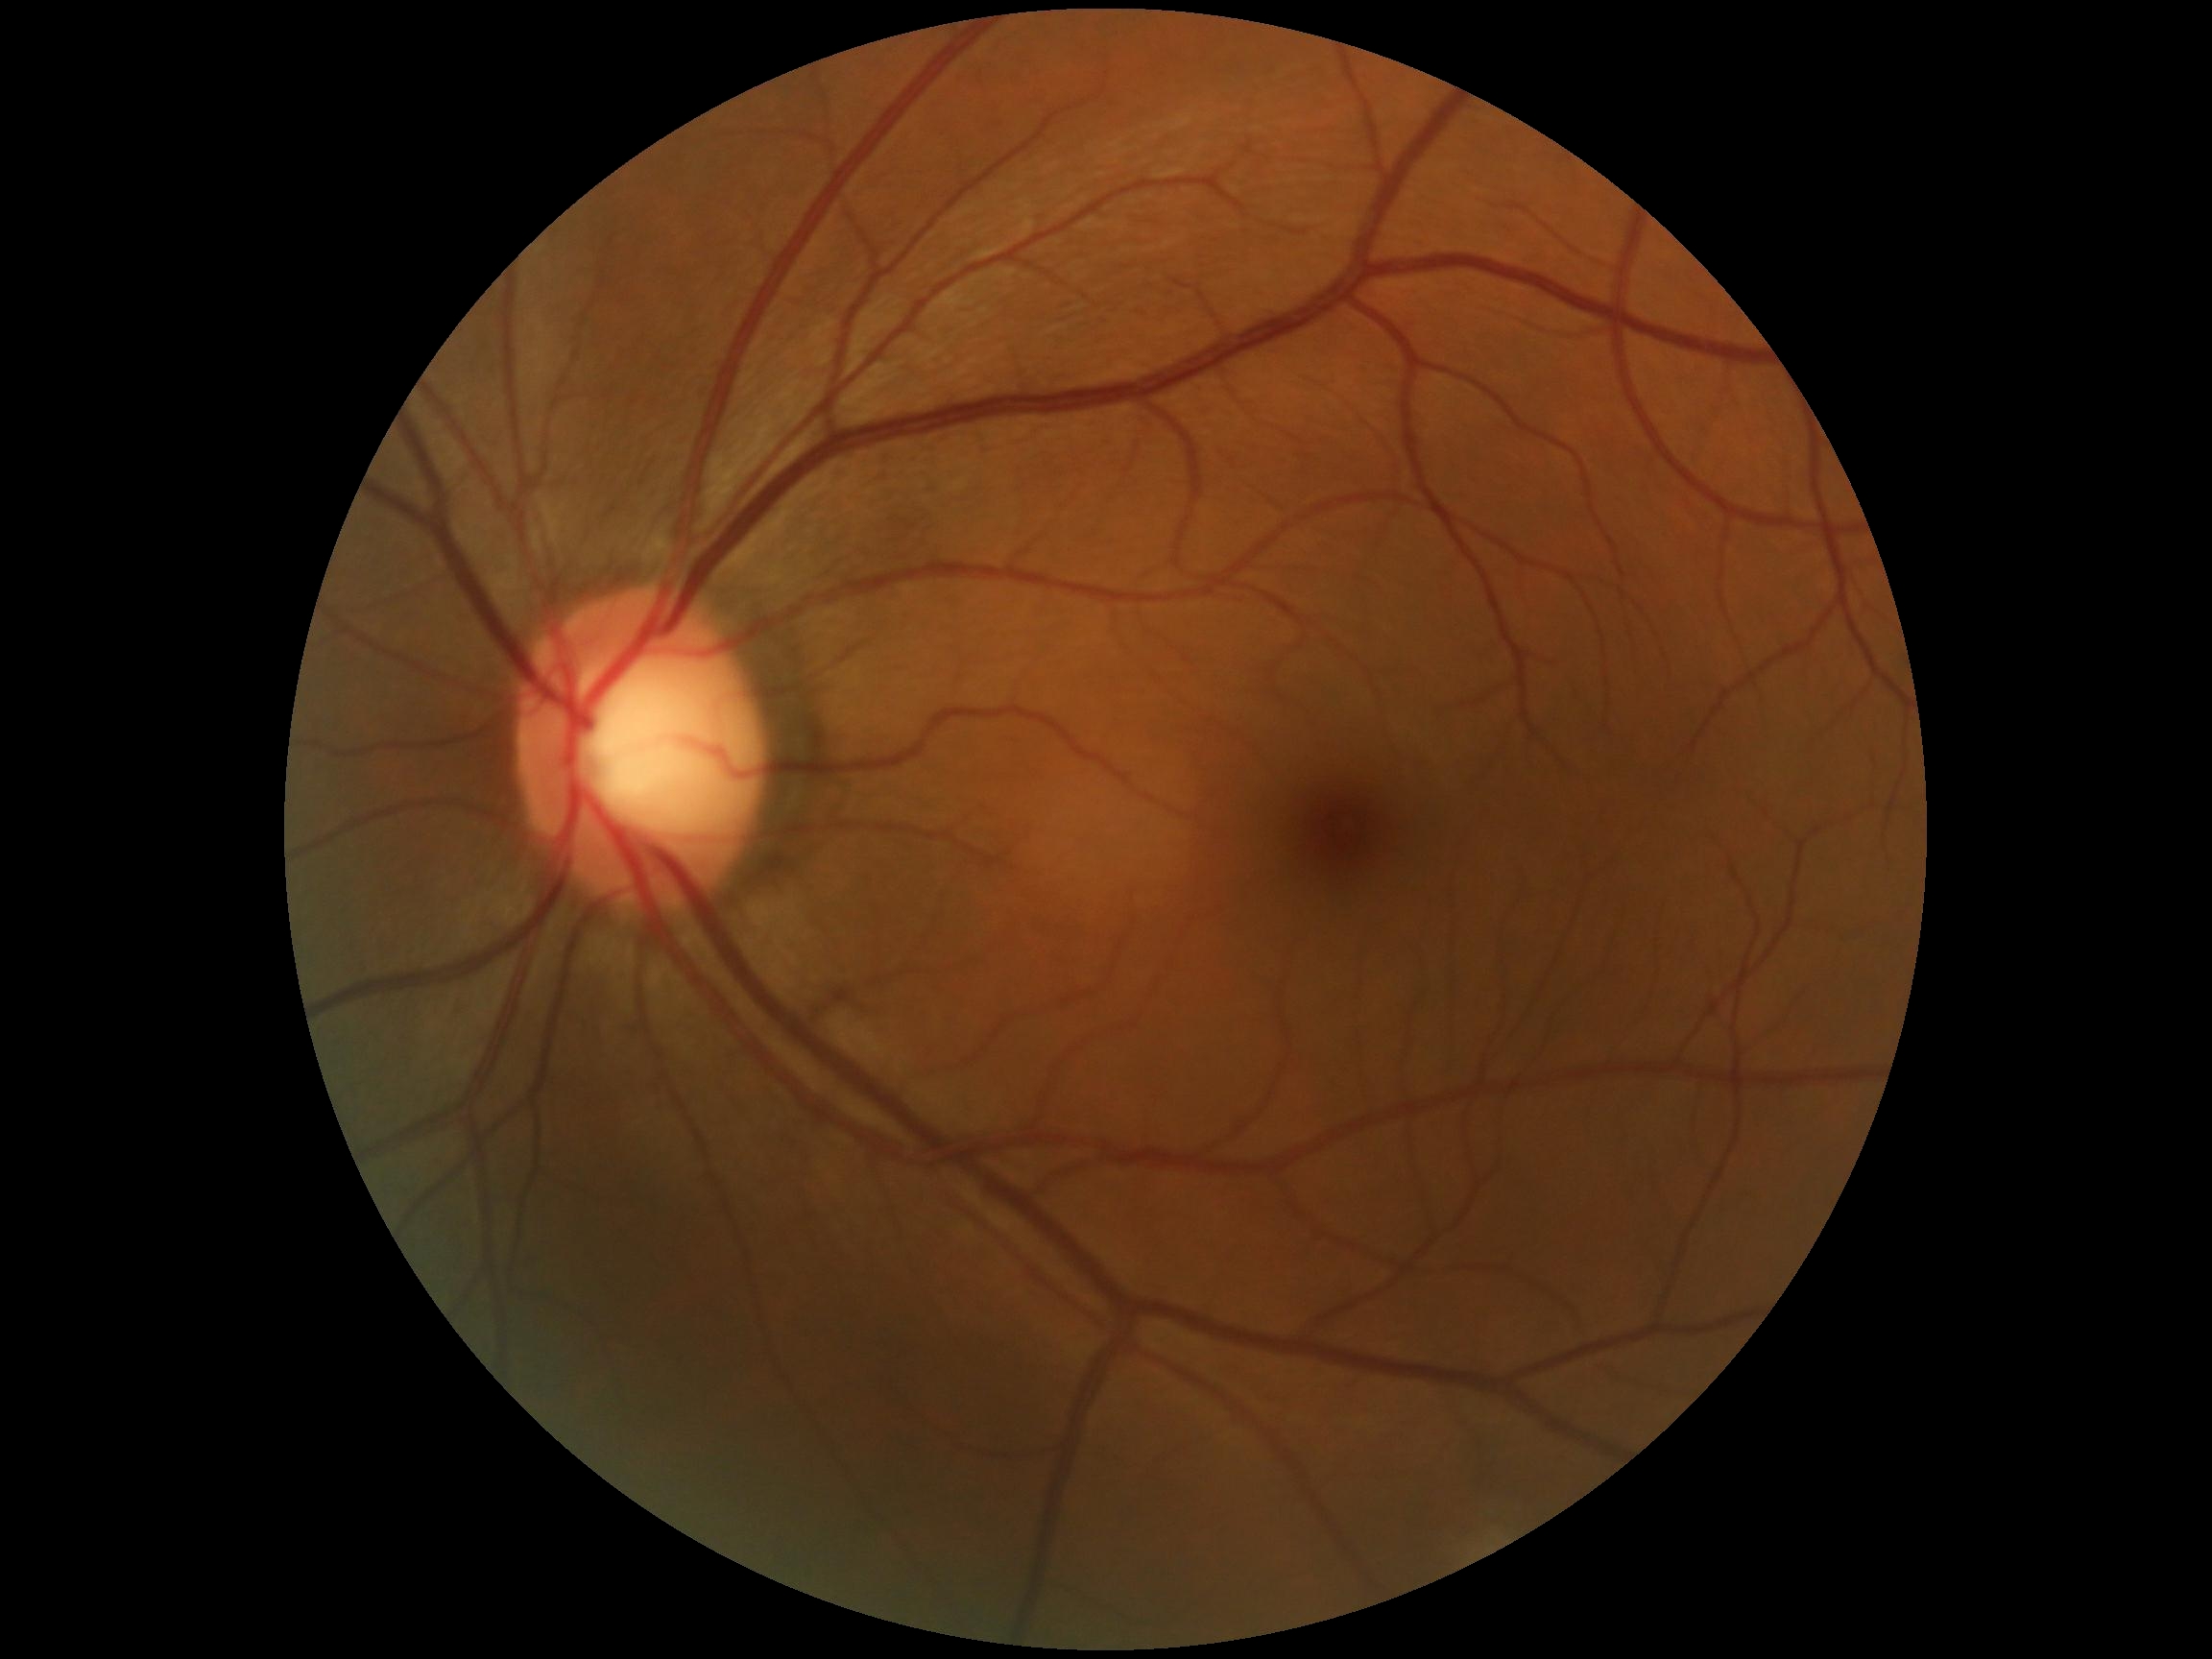

Diabetic retinopathy: 0 — no visible signs of diabetic retinopathy.